Image size 2352x1568 — 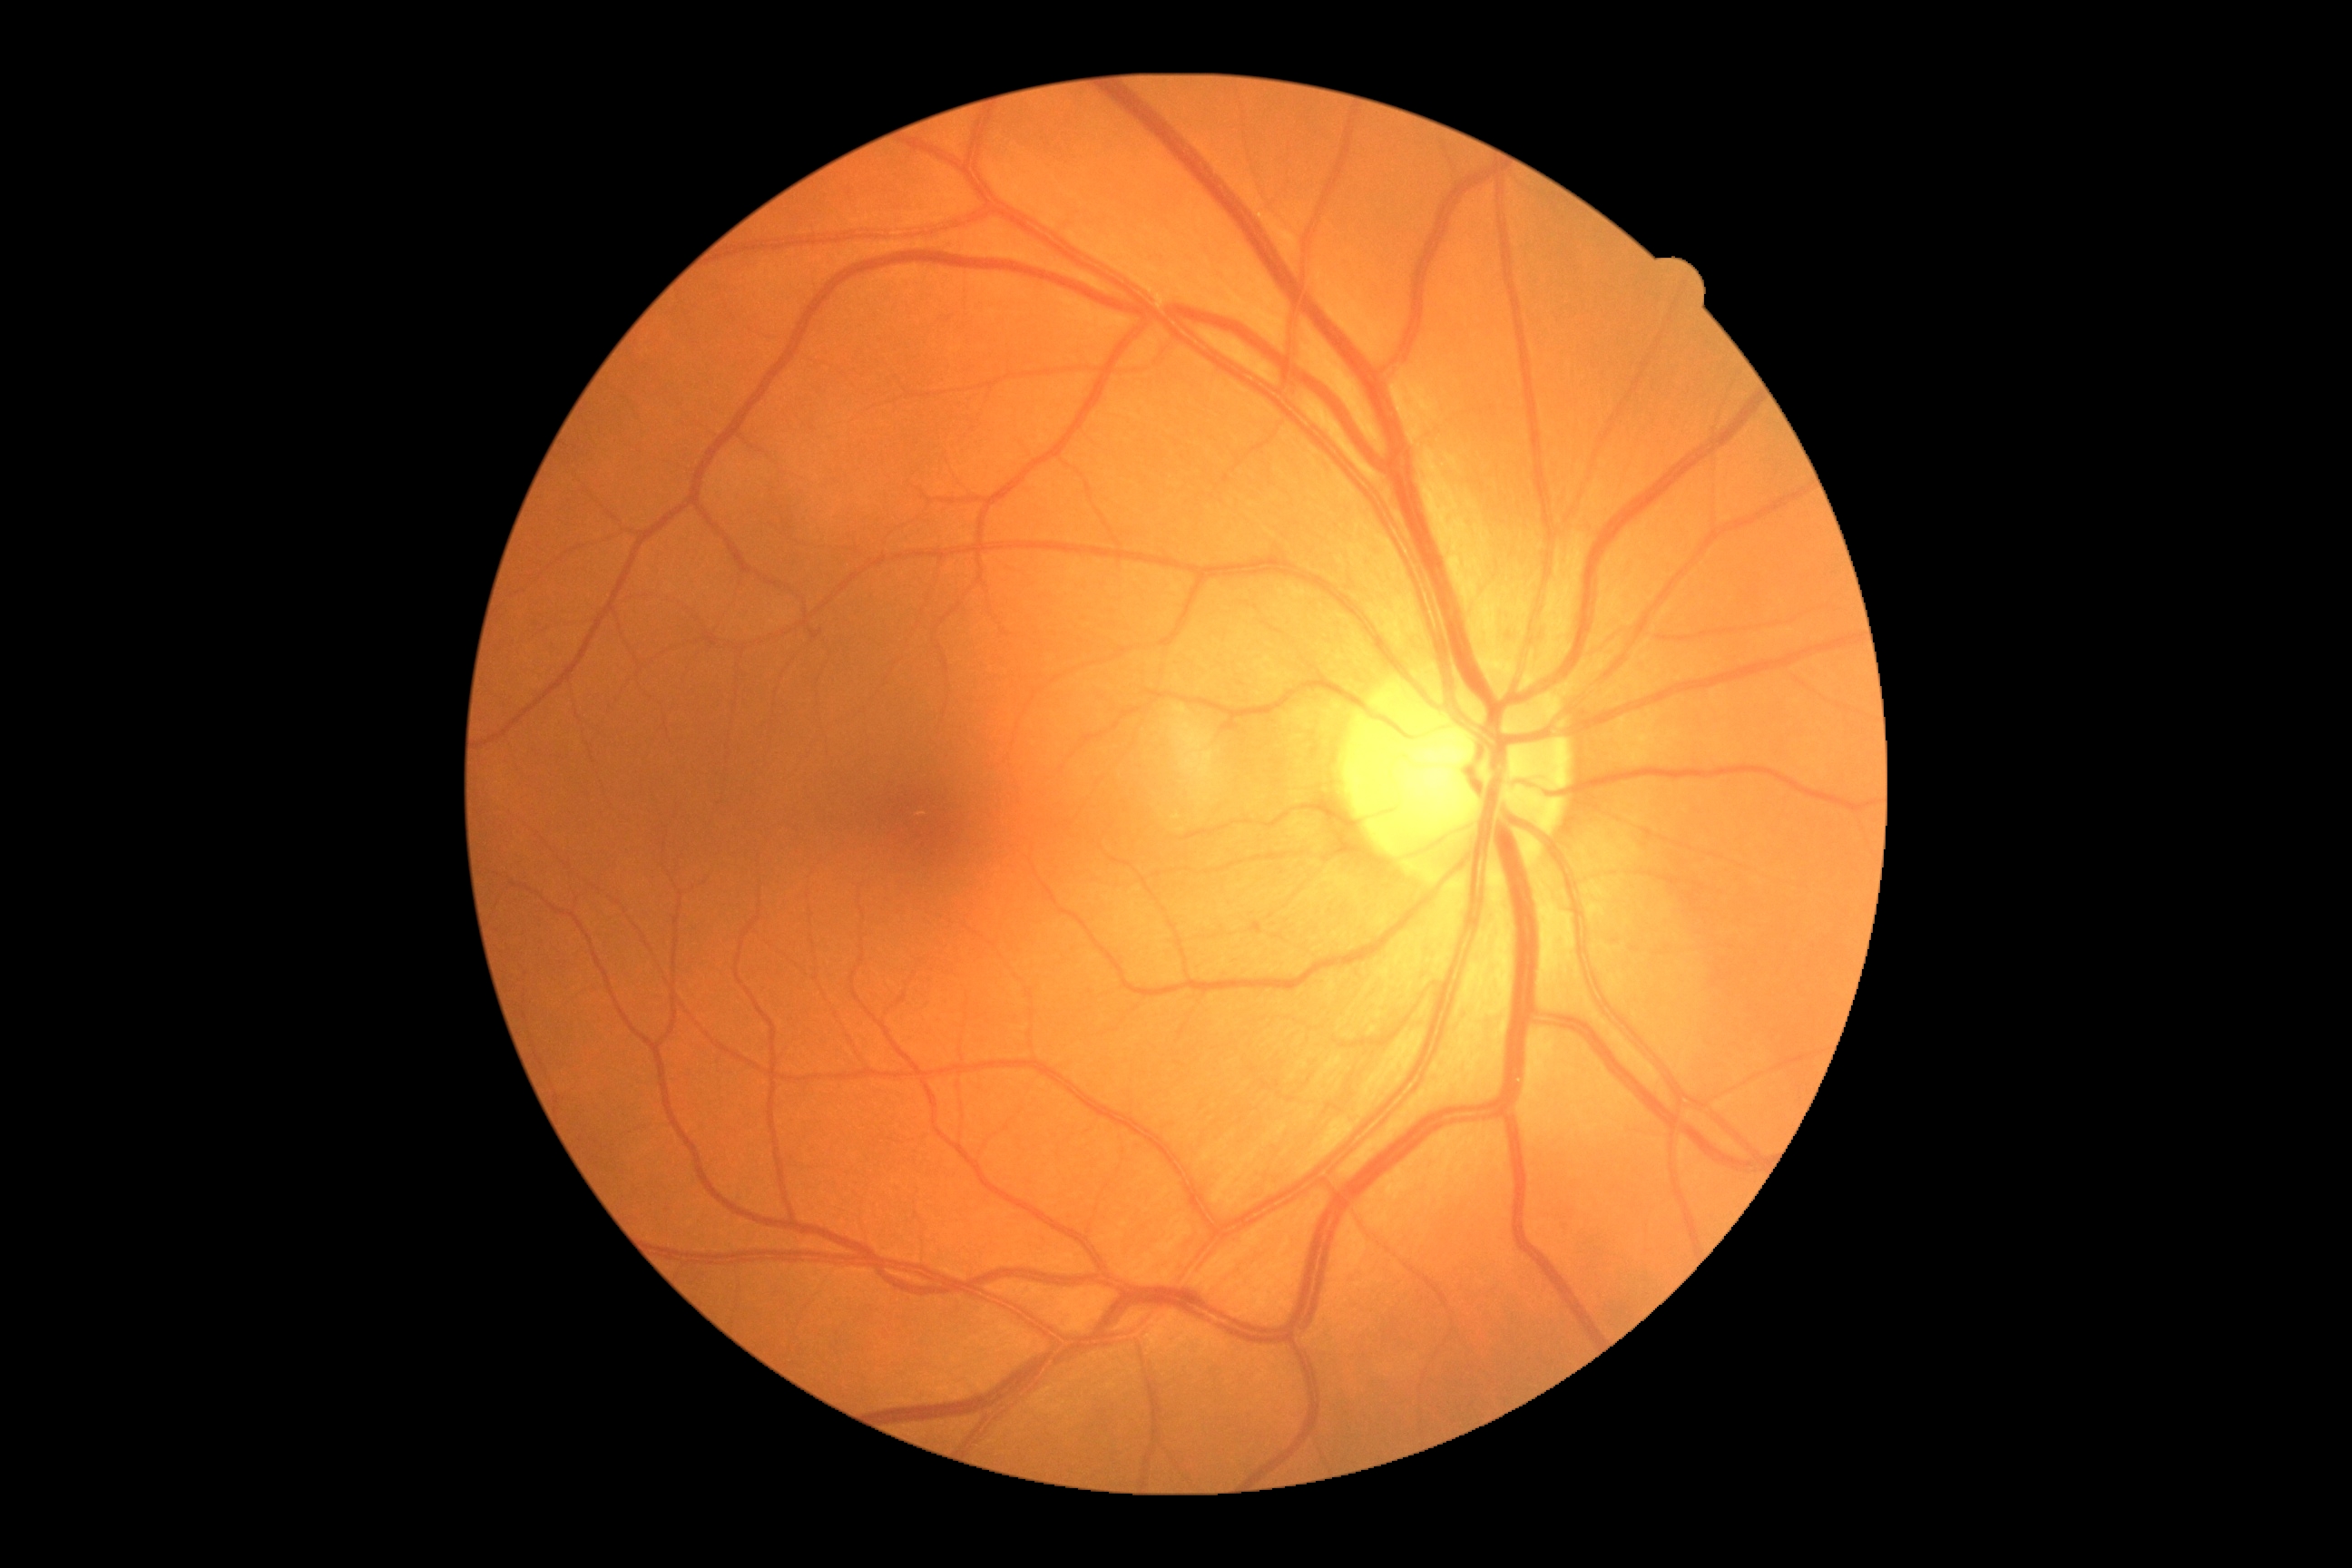 No DR findings. Diabetic retinopathy severity is 0.